45-degree field of view. Fundus photo — 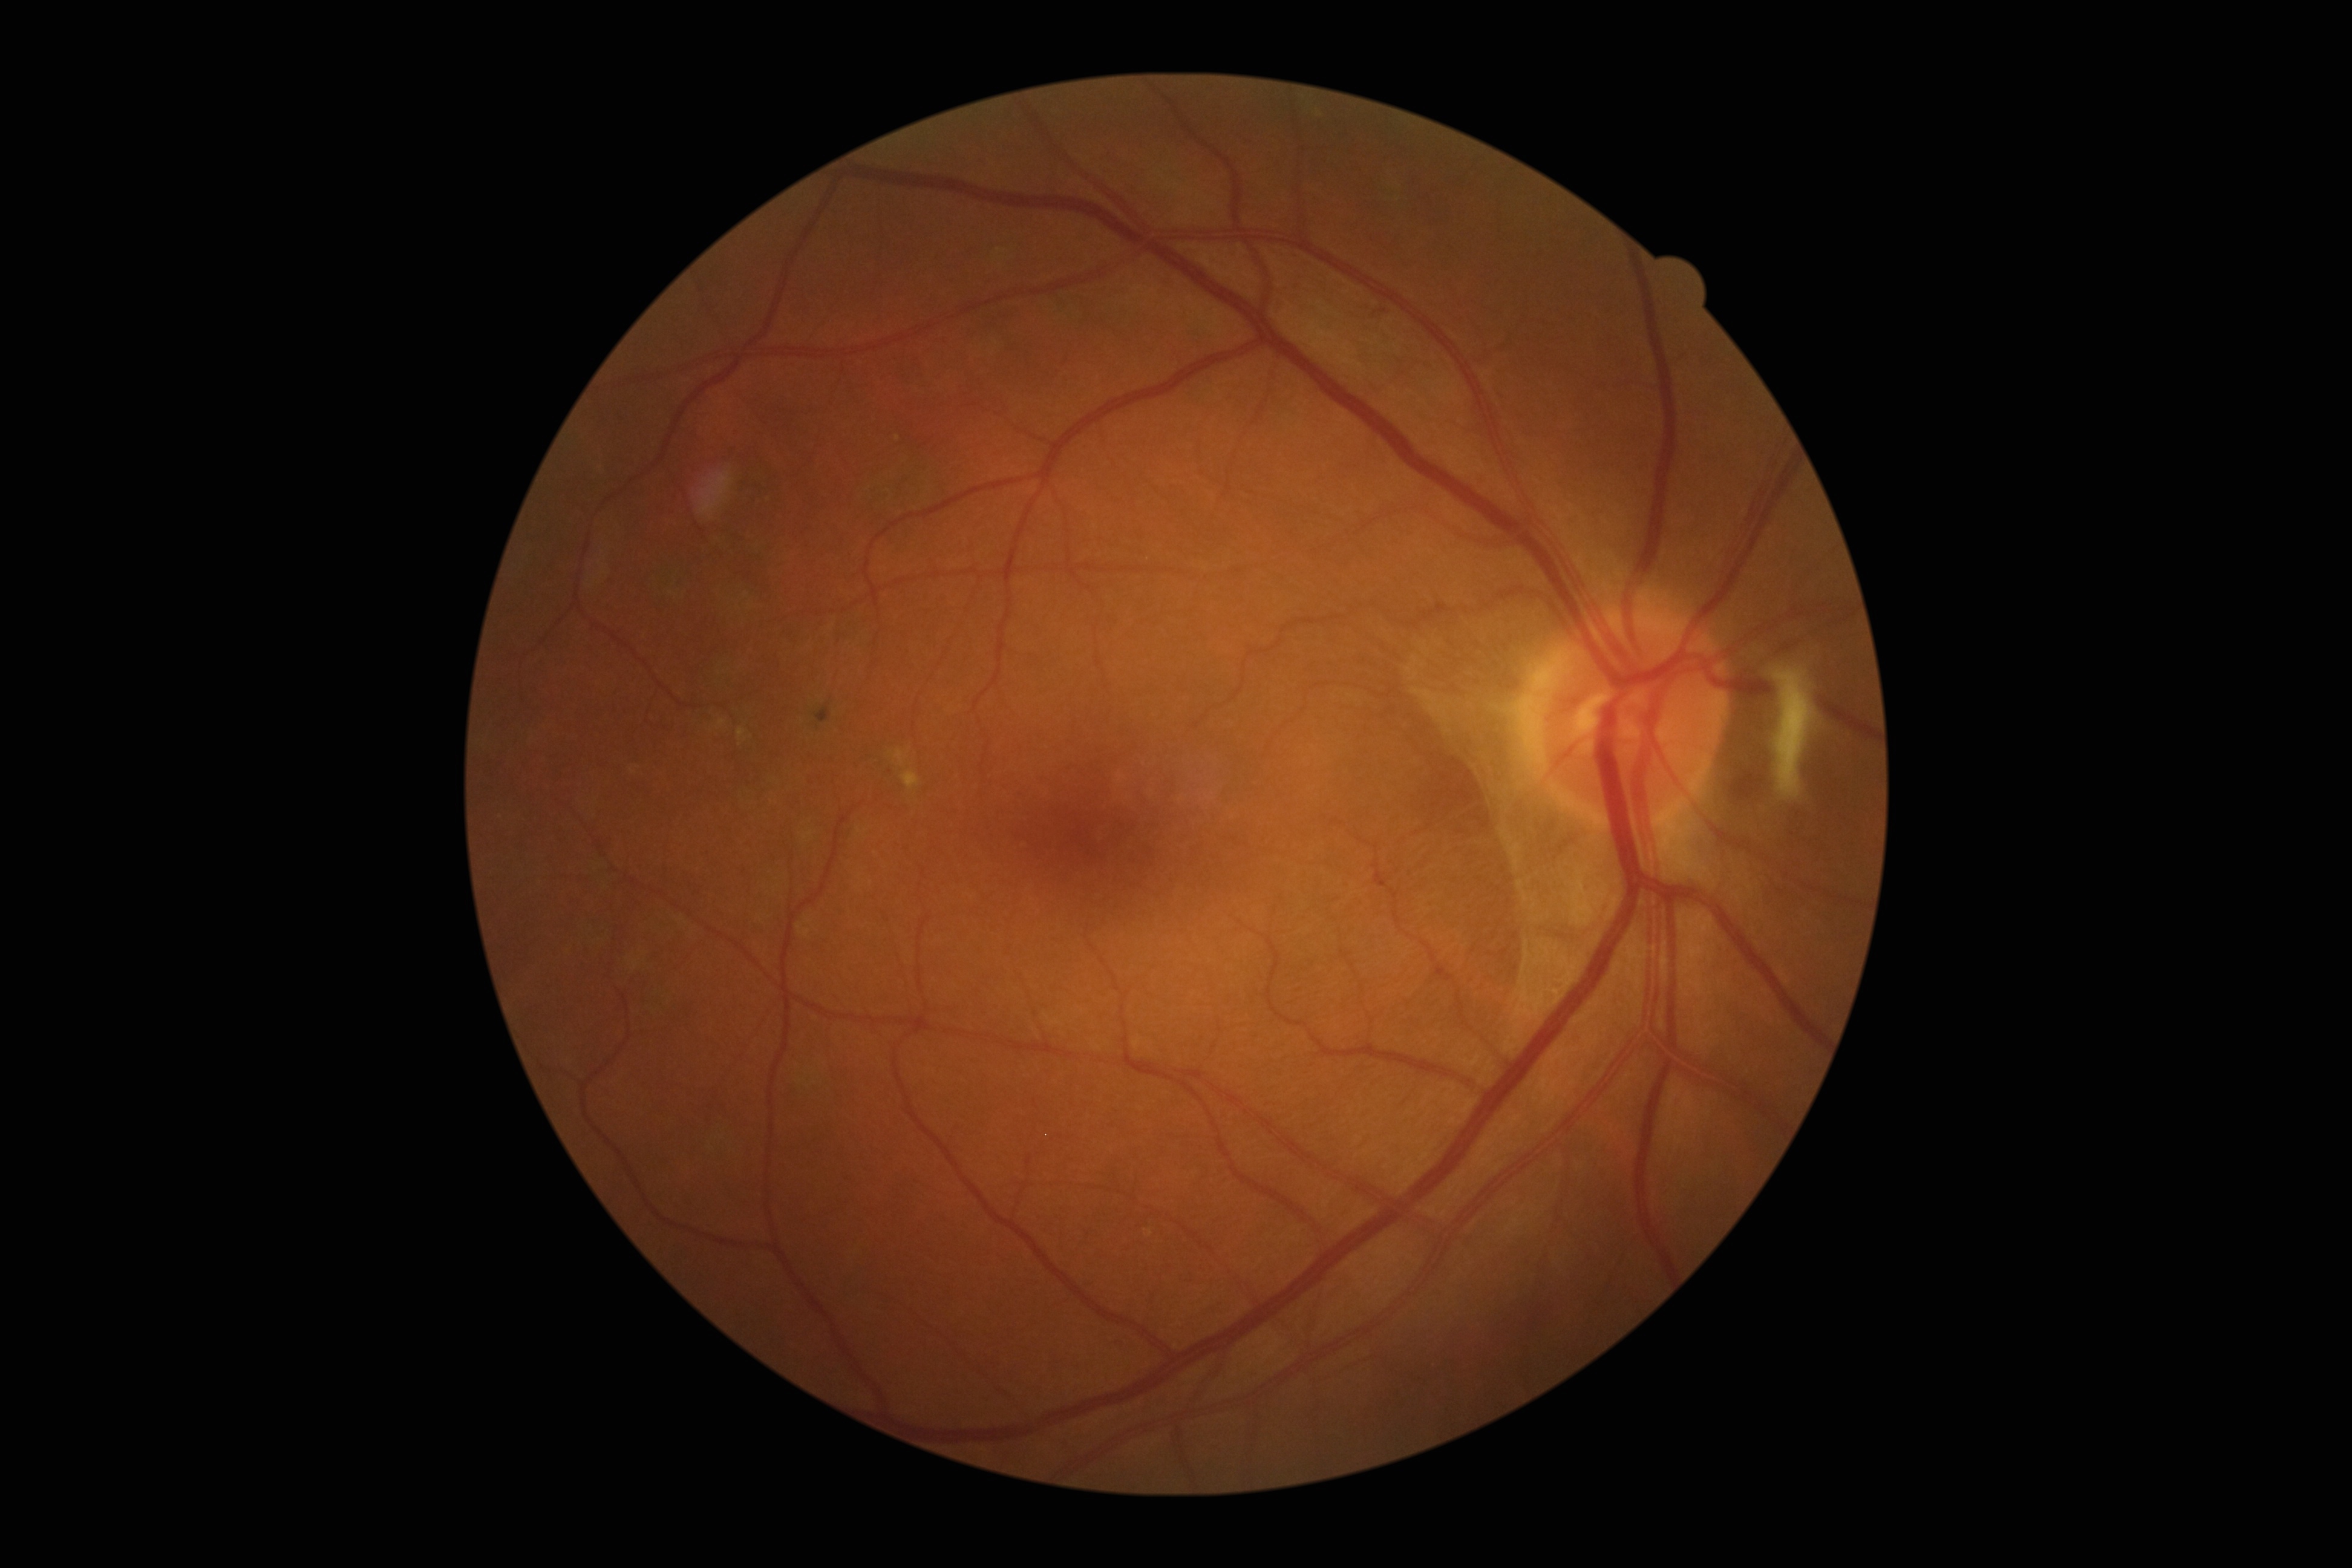

dr_grade: grade 4 — neovascularization and/or vitreous/pre-retinal hemorrhage